Phoenix ICON wide-field infant fundus image · 100° field of view (Phoenix ICON):
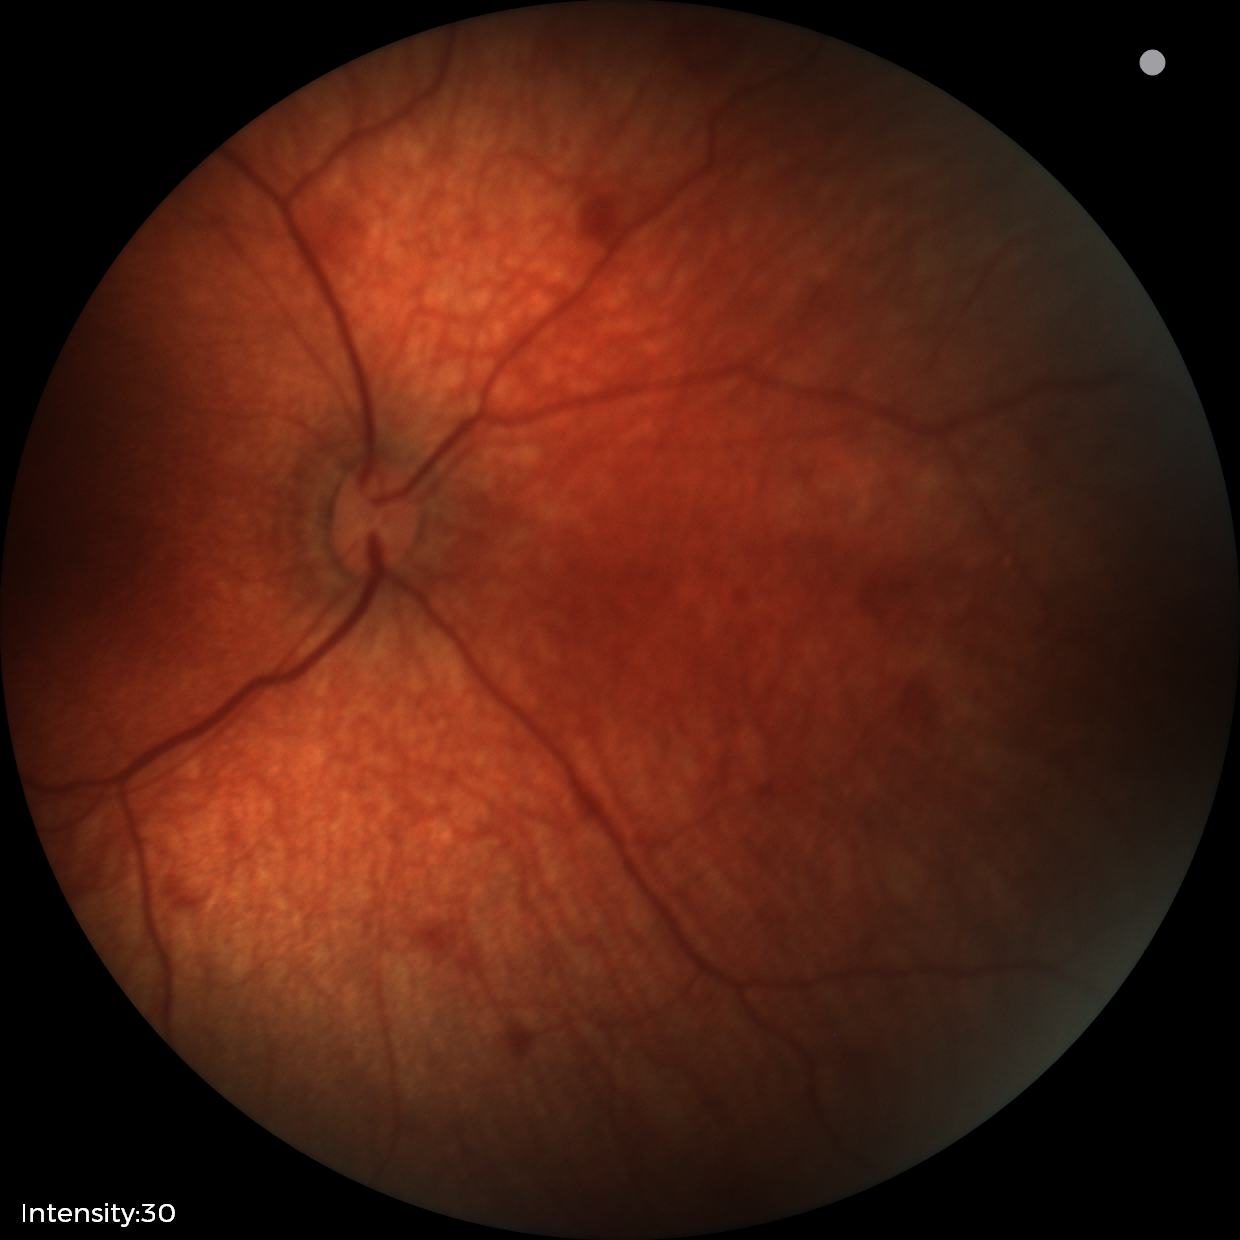
Examination diagnosed as retinal hemorrhages.